2352 x 1568 pixels:
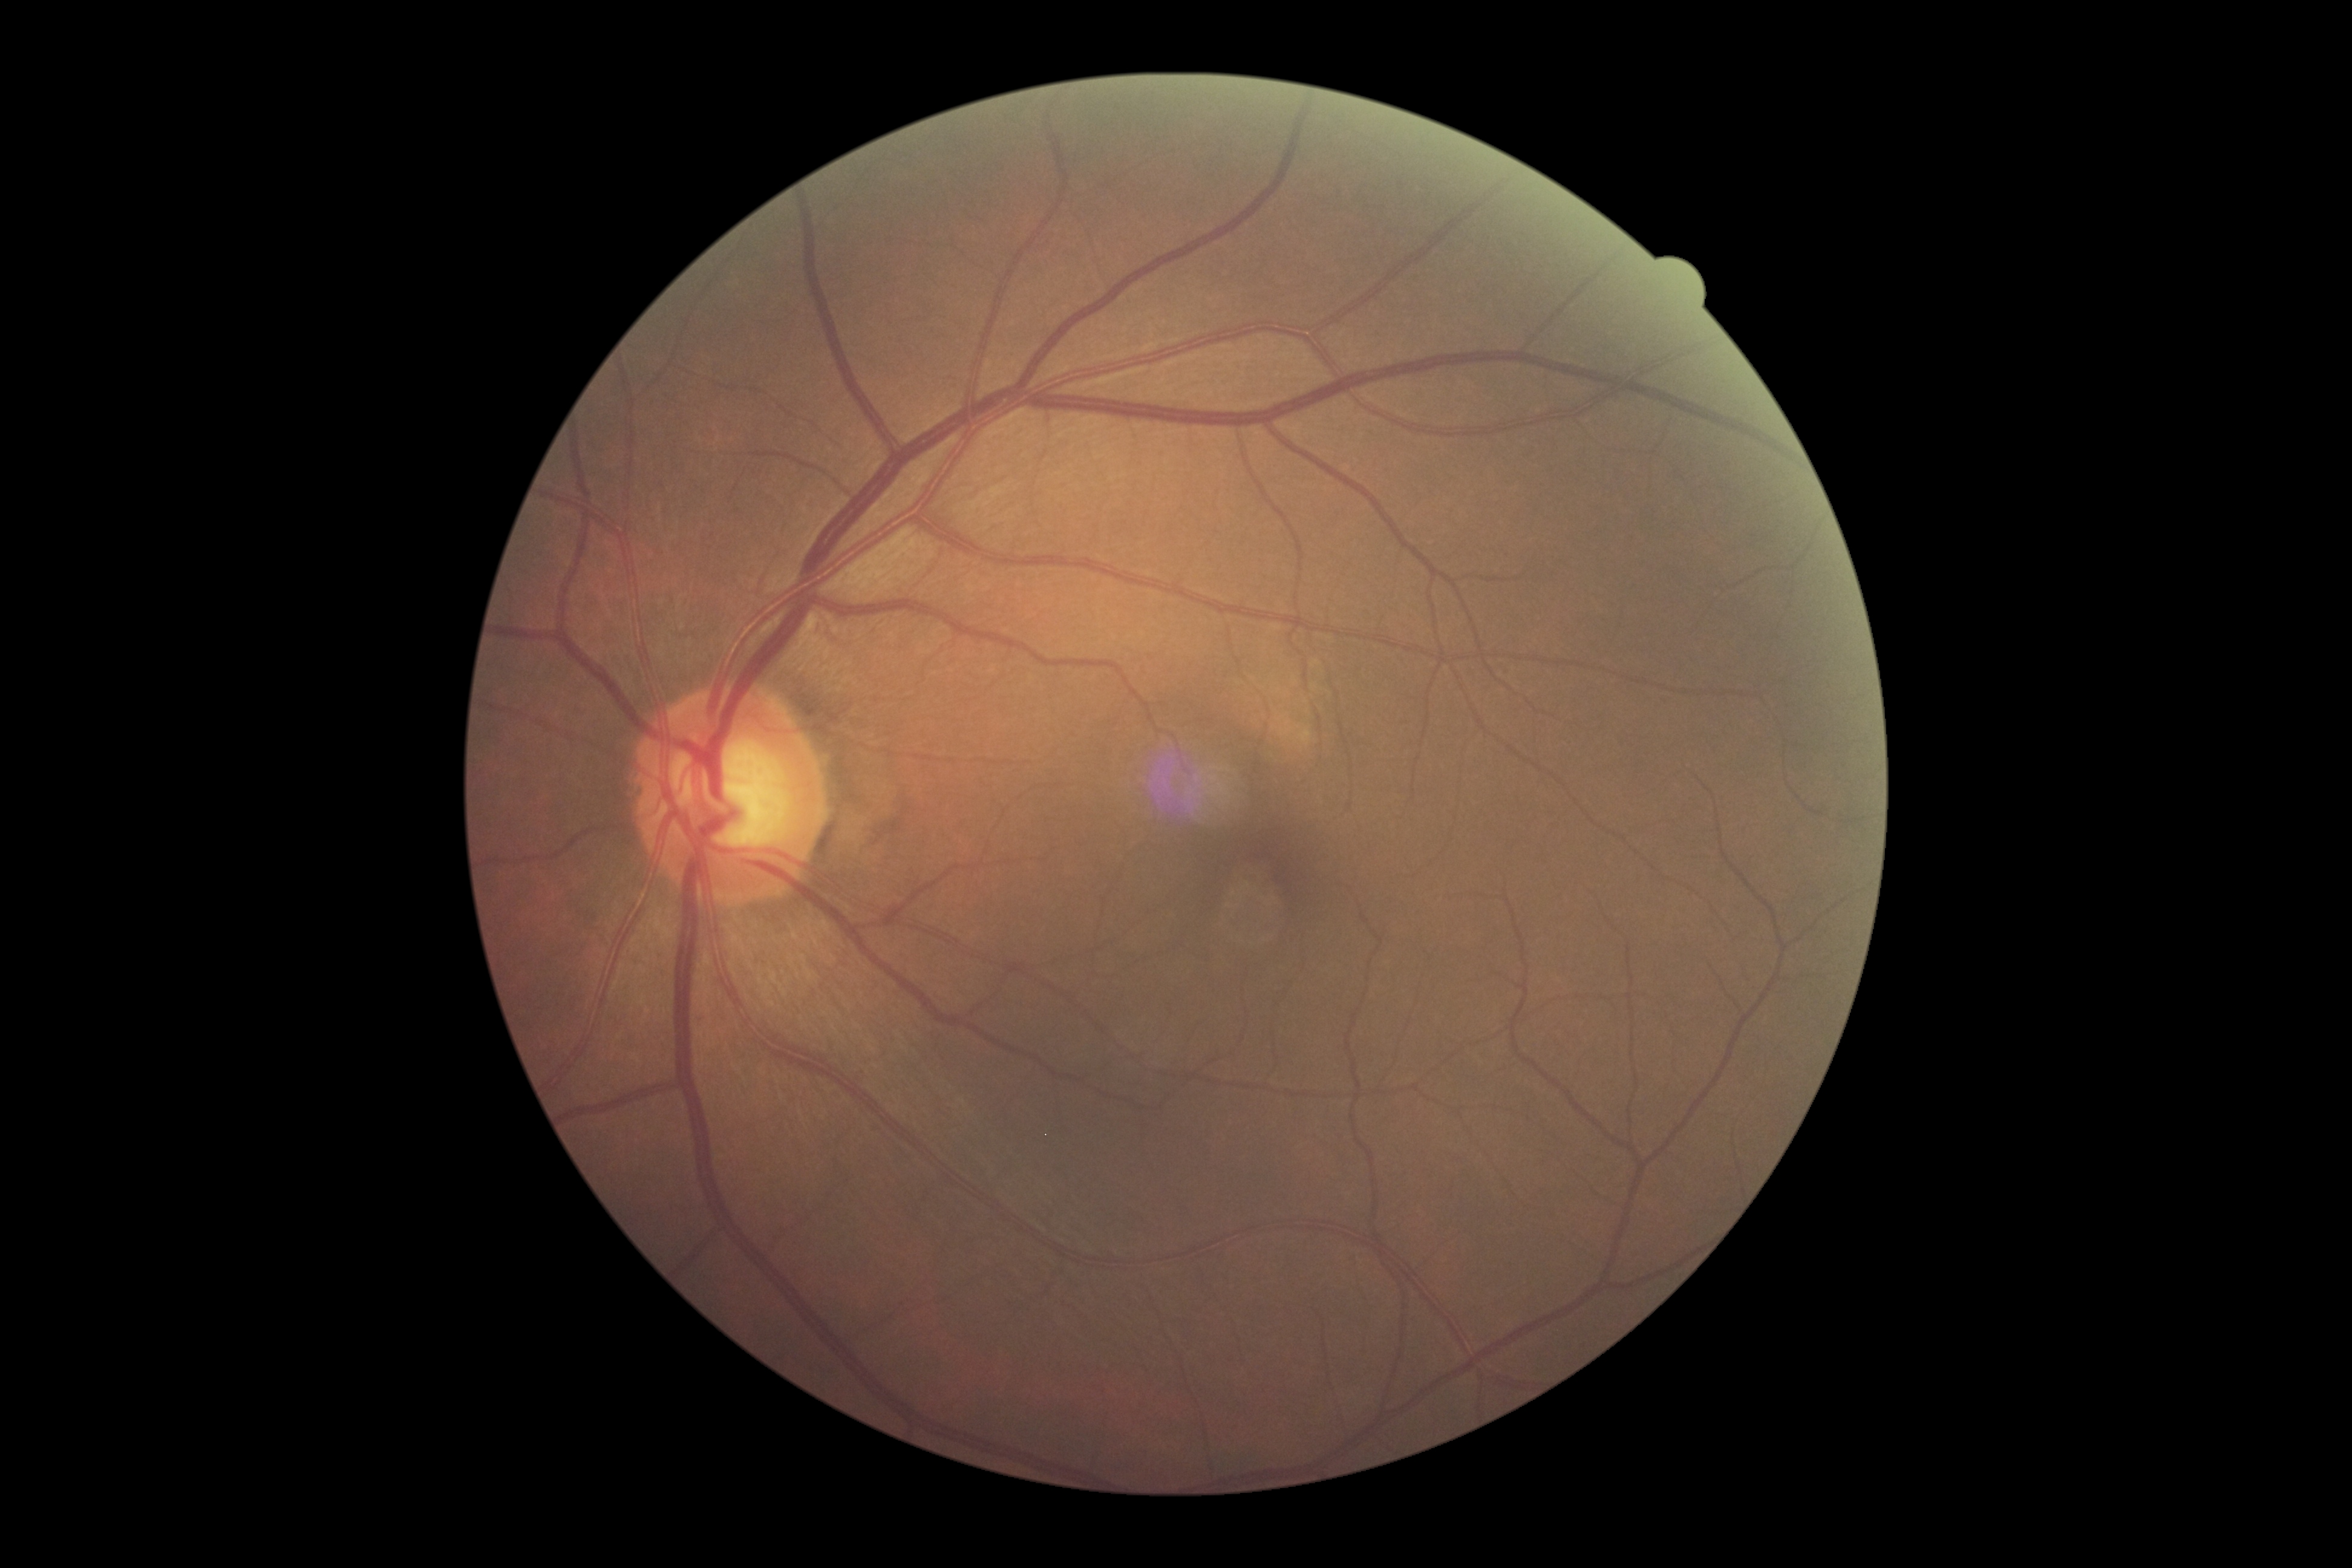

DR is grade 0 (no apparent retinopathy) — no visible signs of diabetic retinopathy.